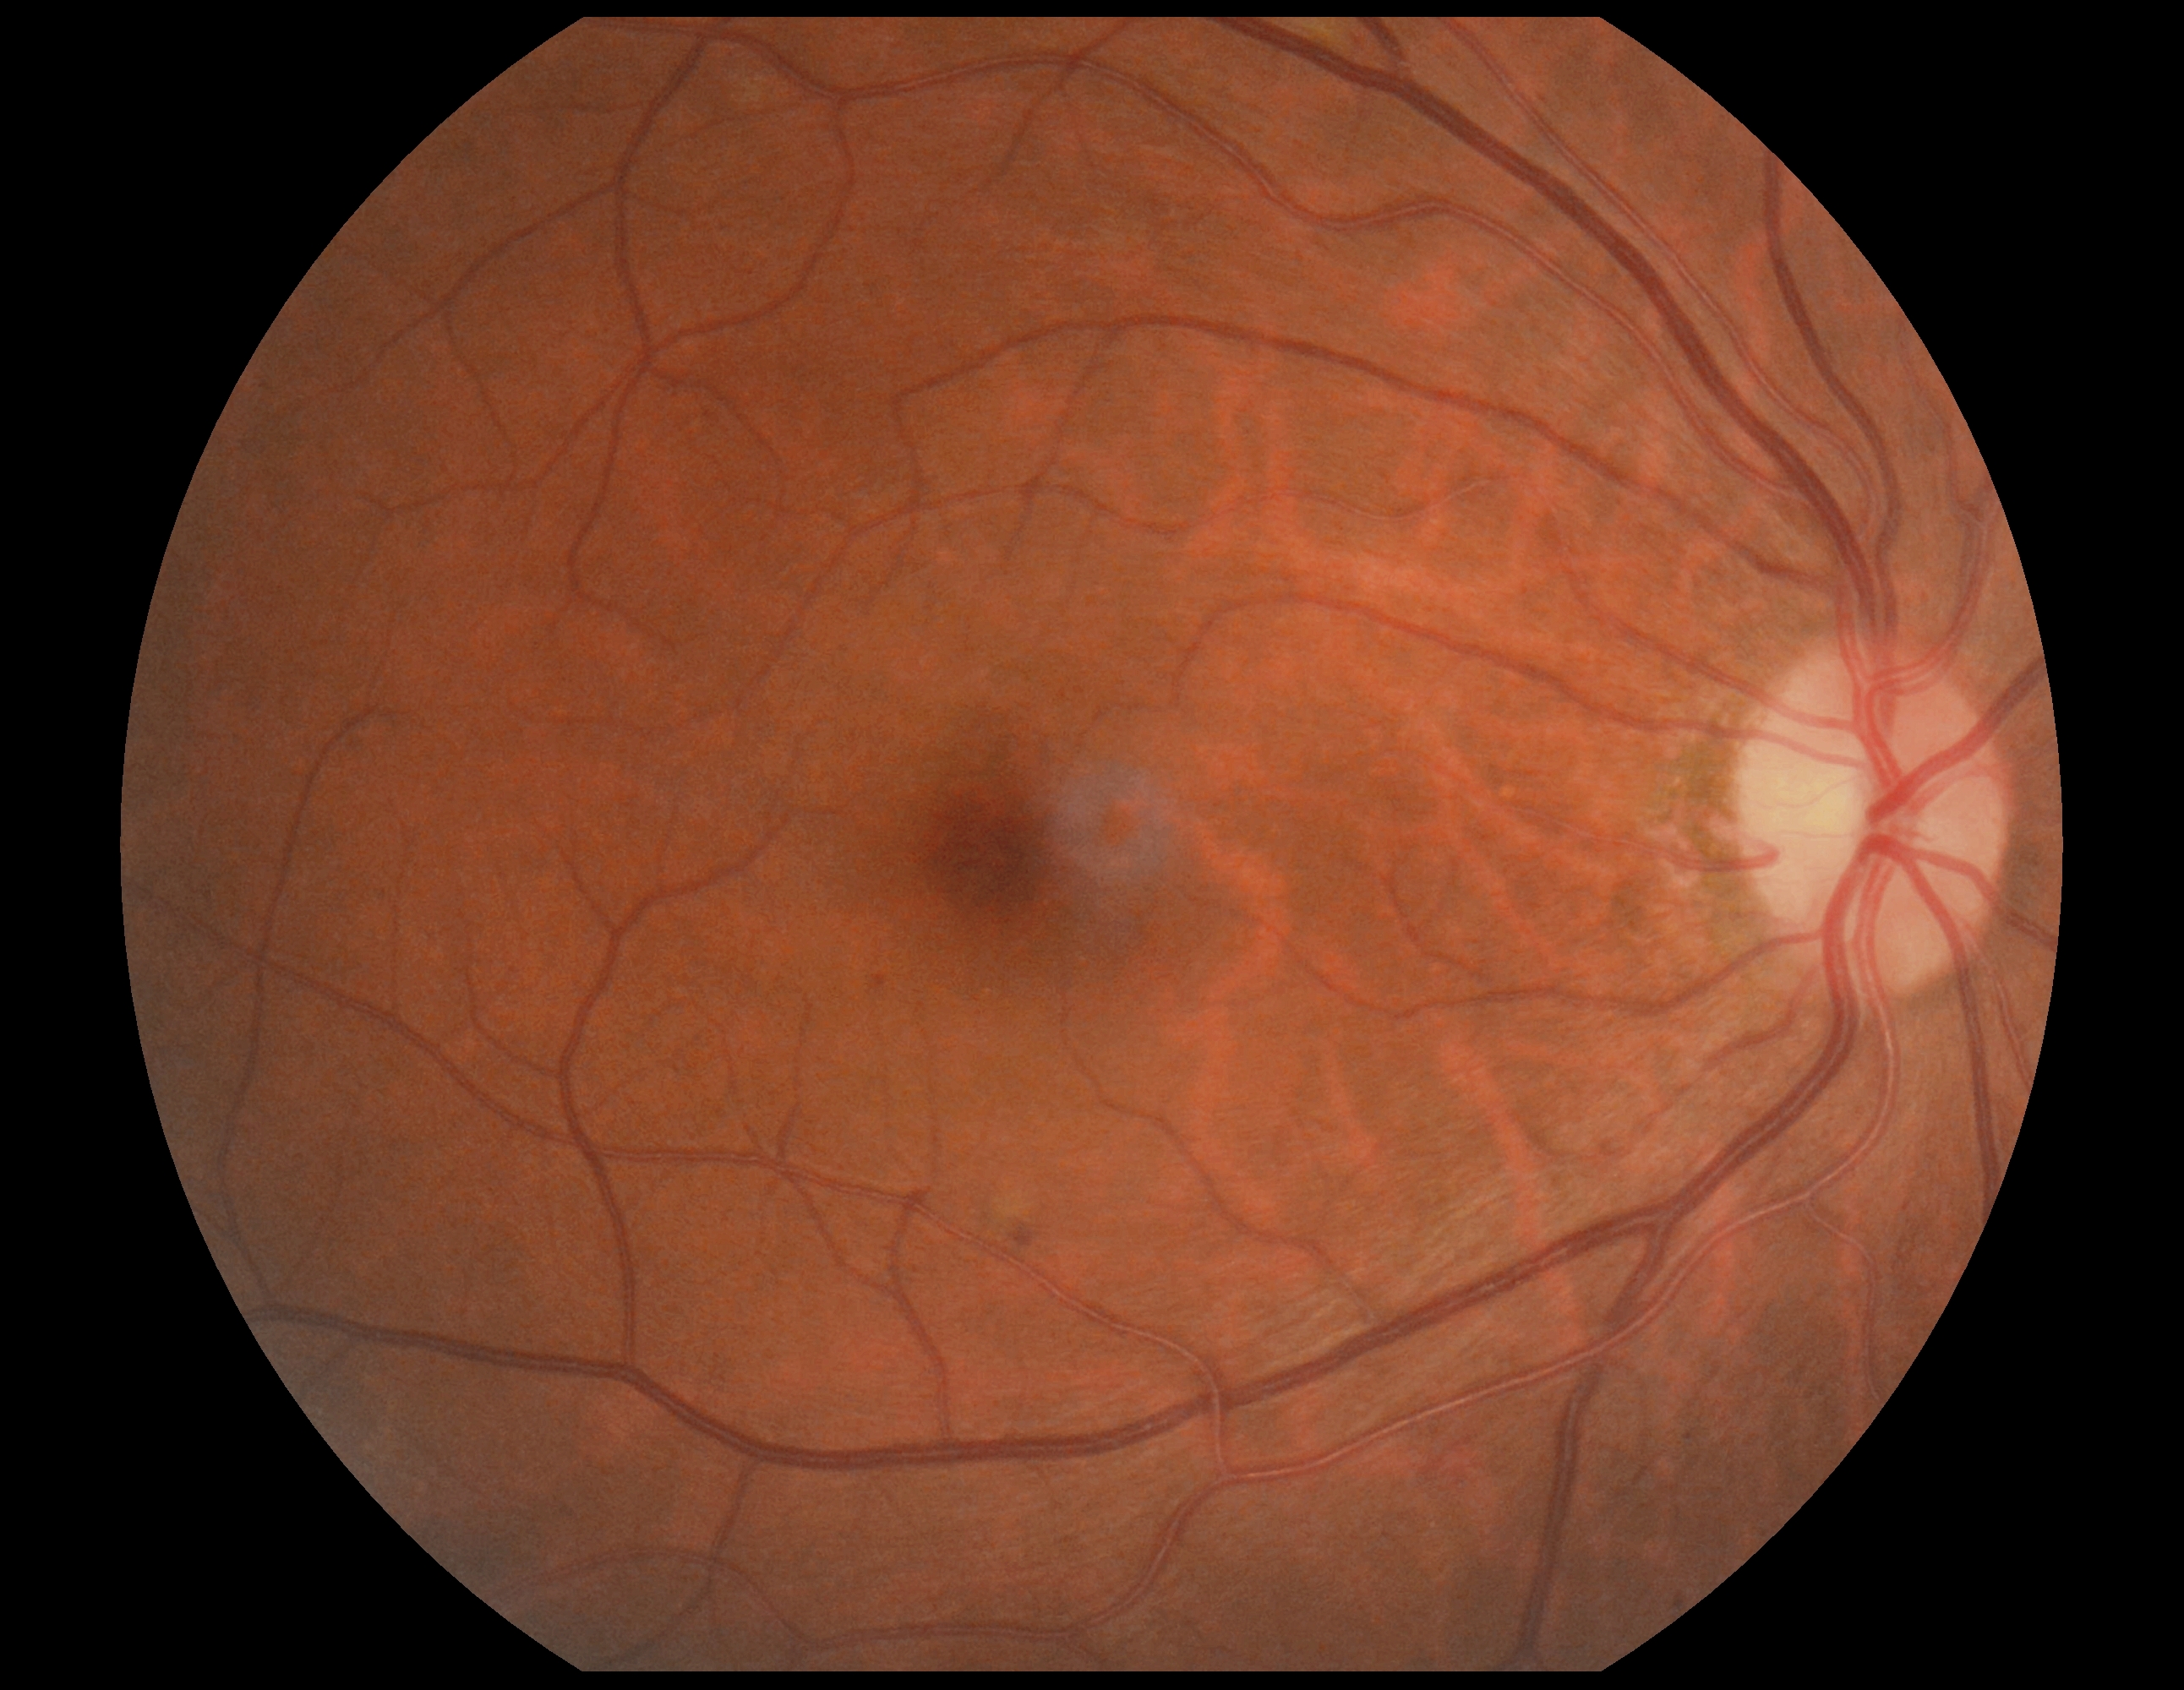

retinopathy grade@2/4.